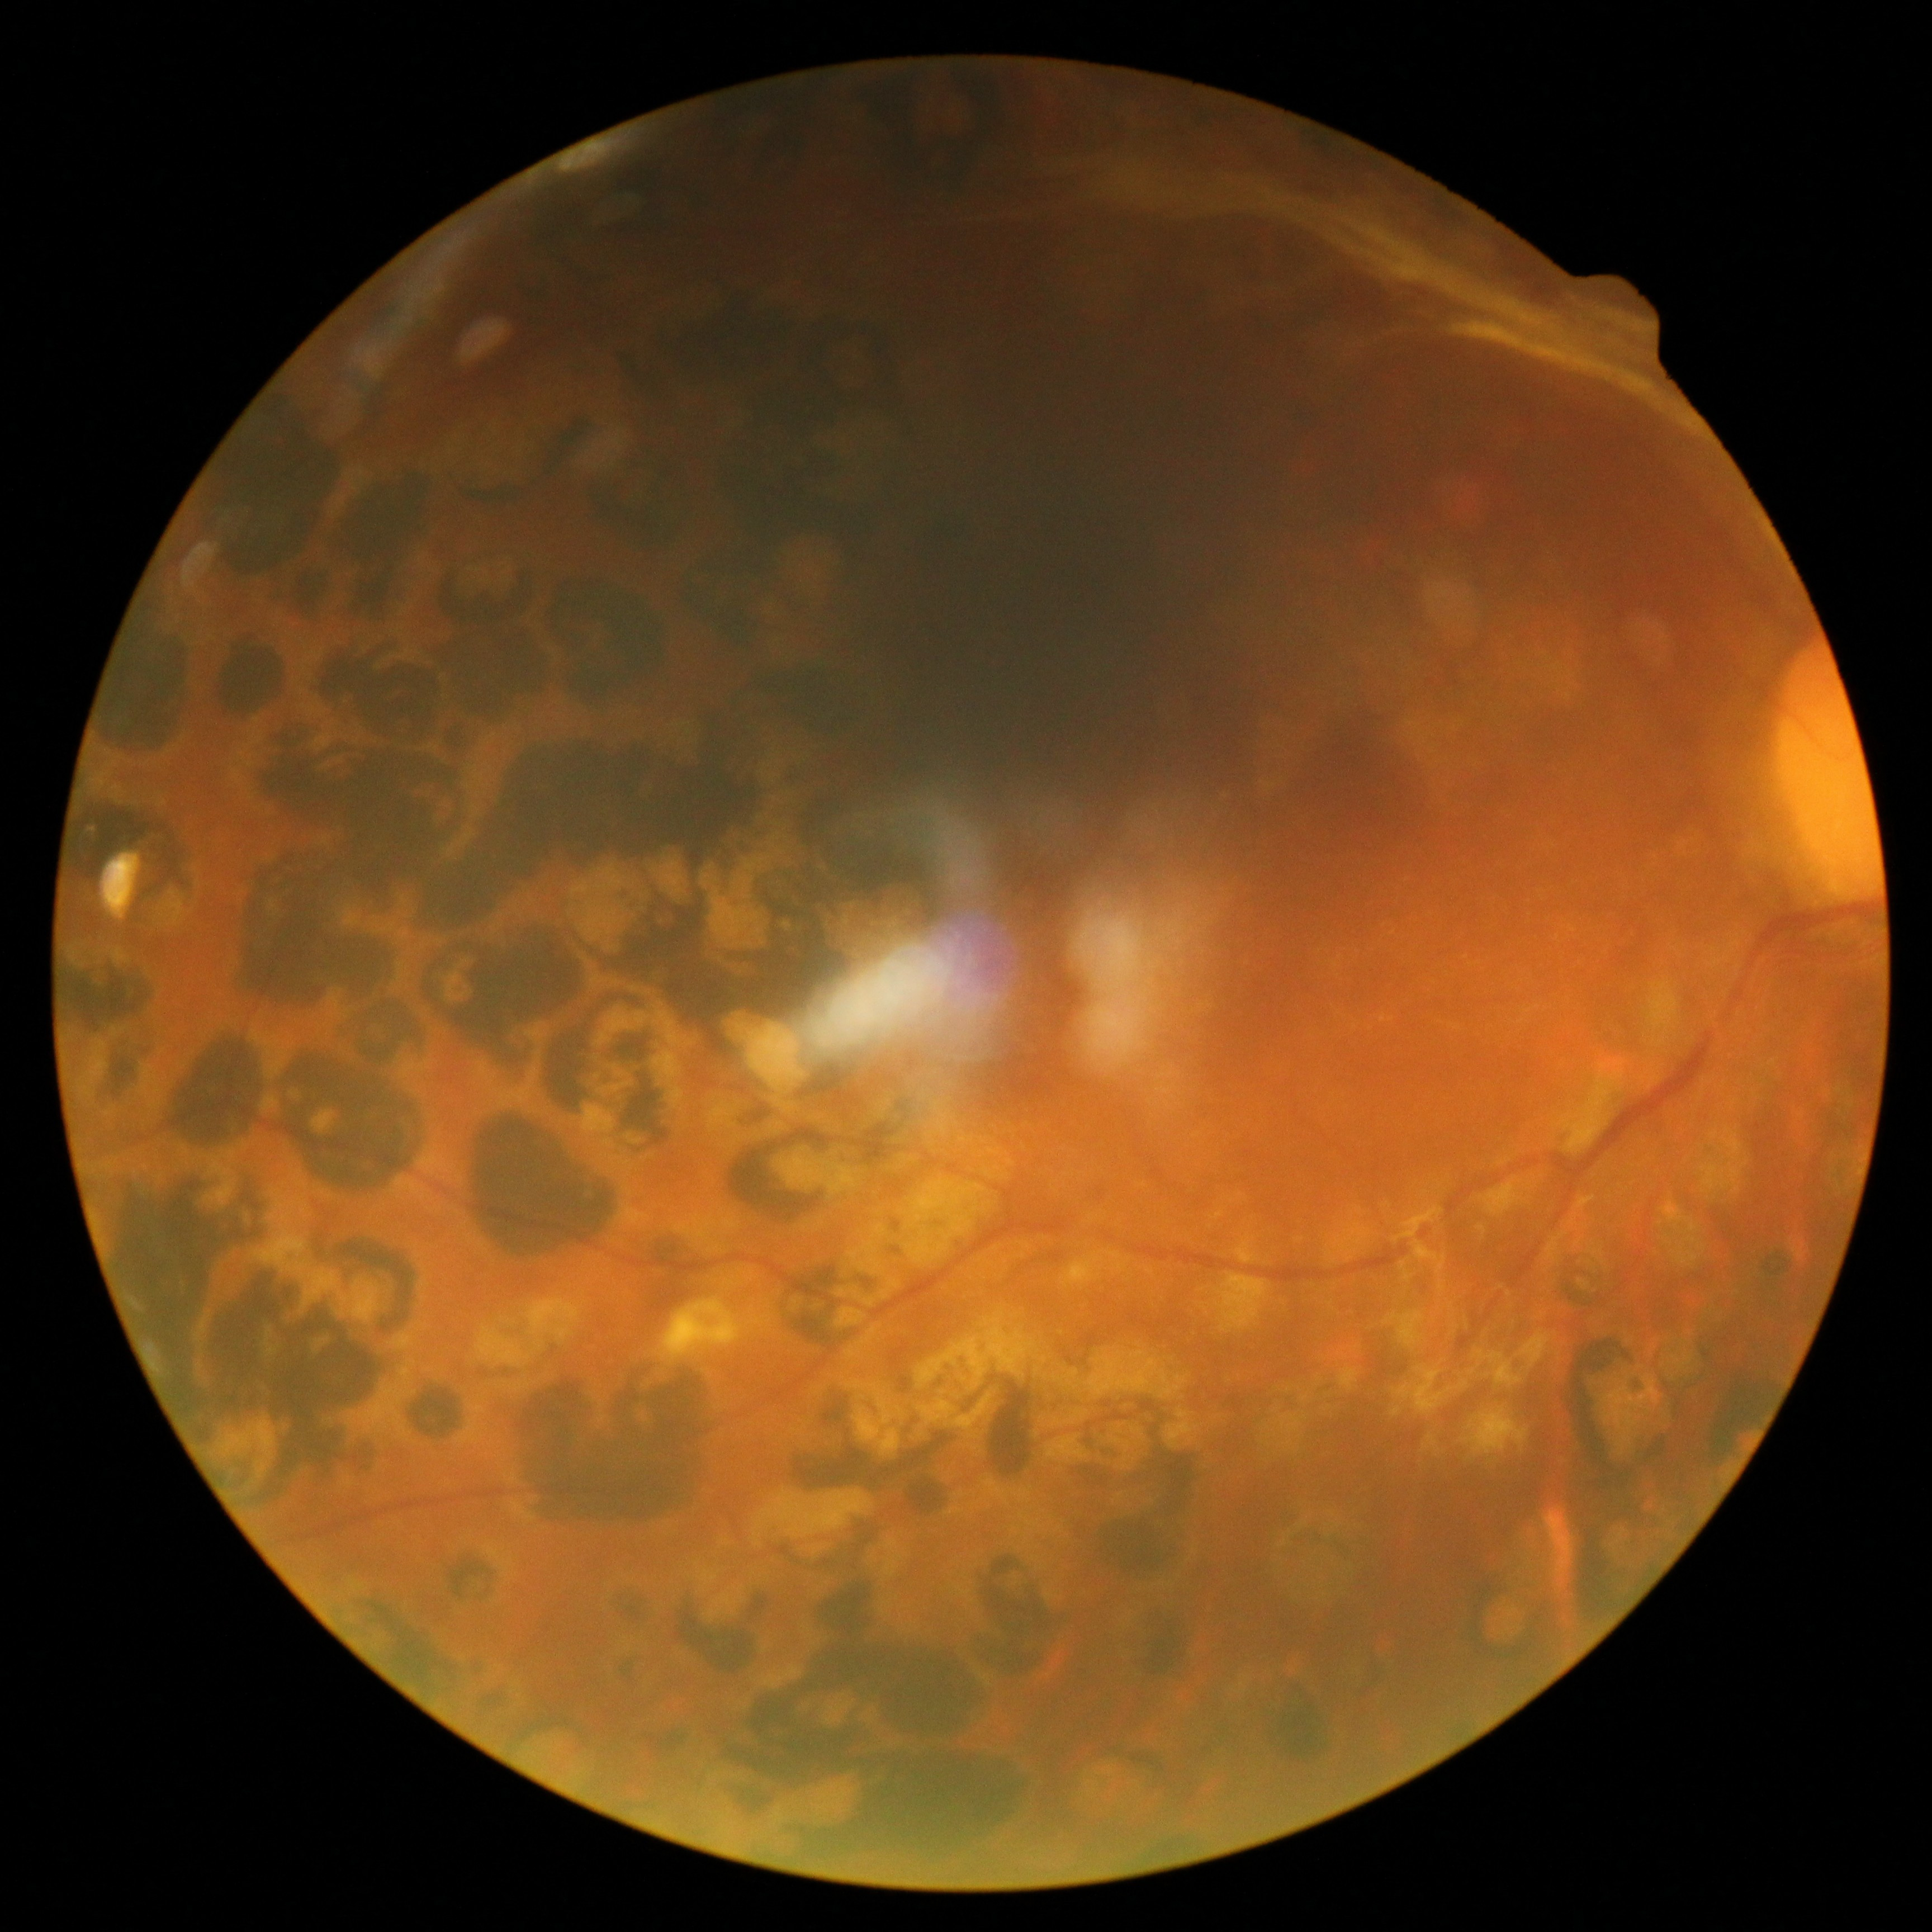
{
  "dr_grade": "4"
}